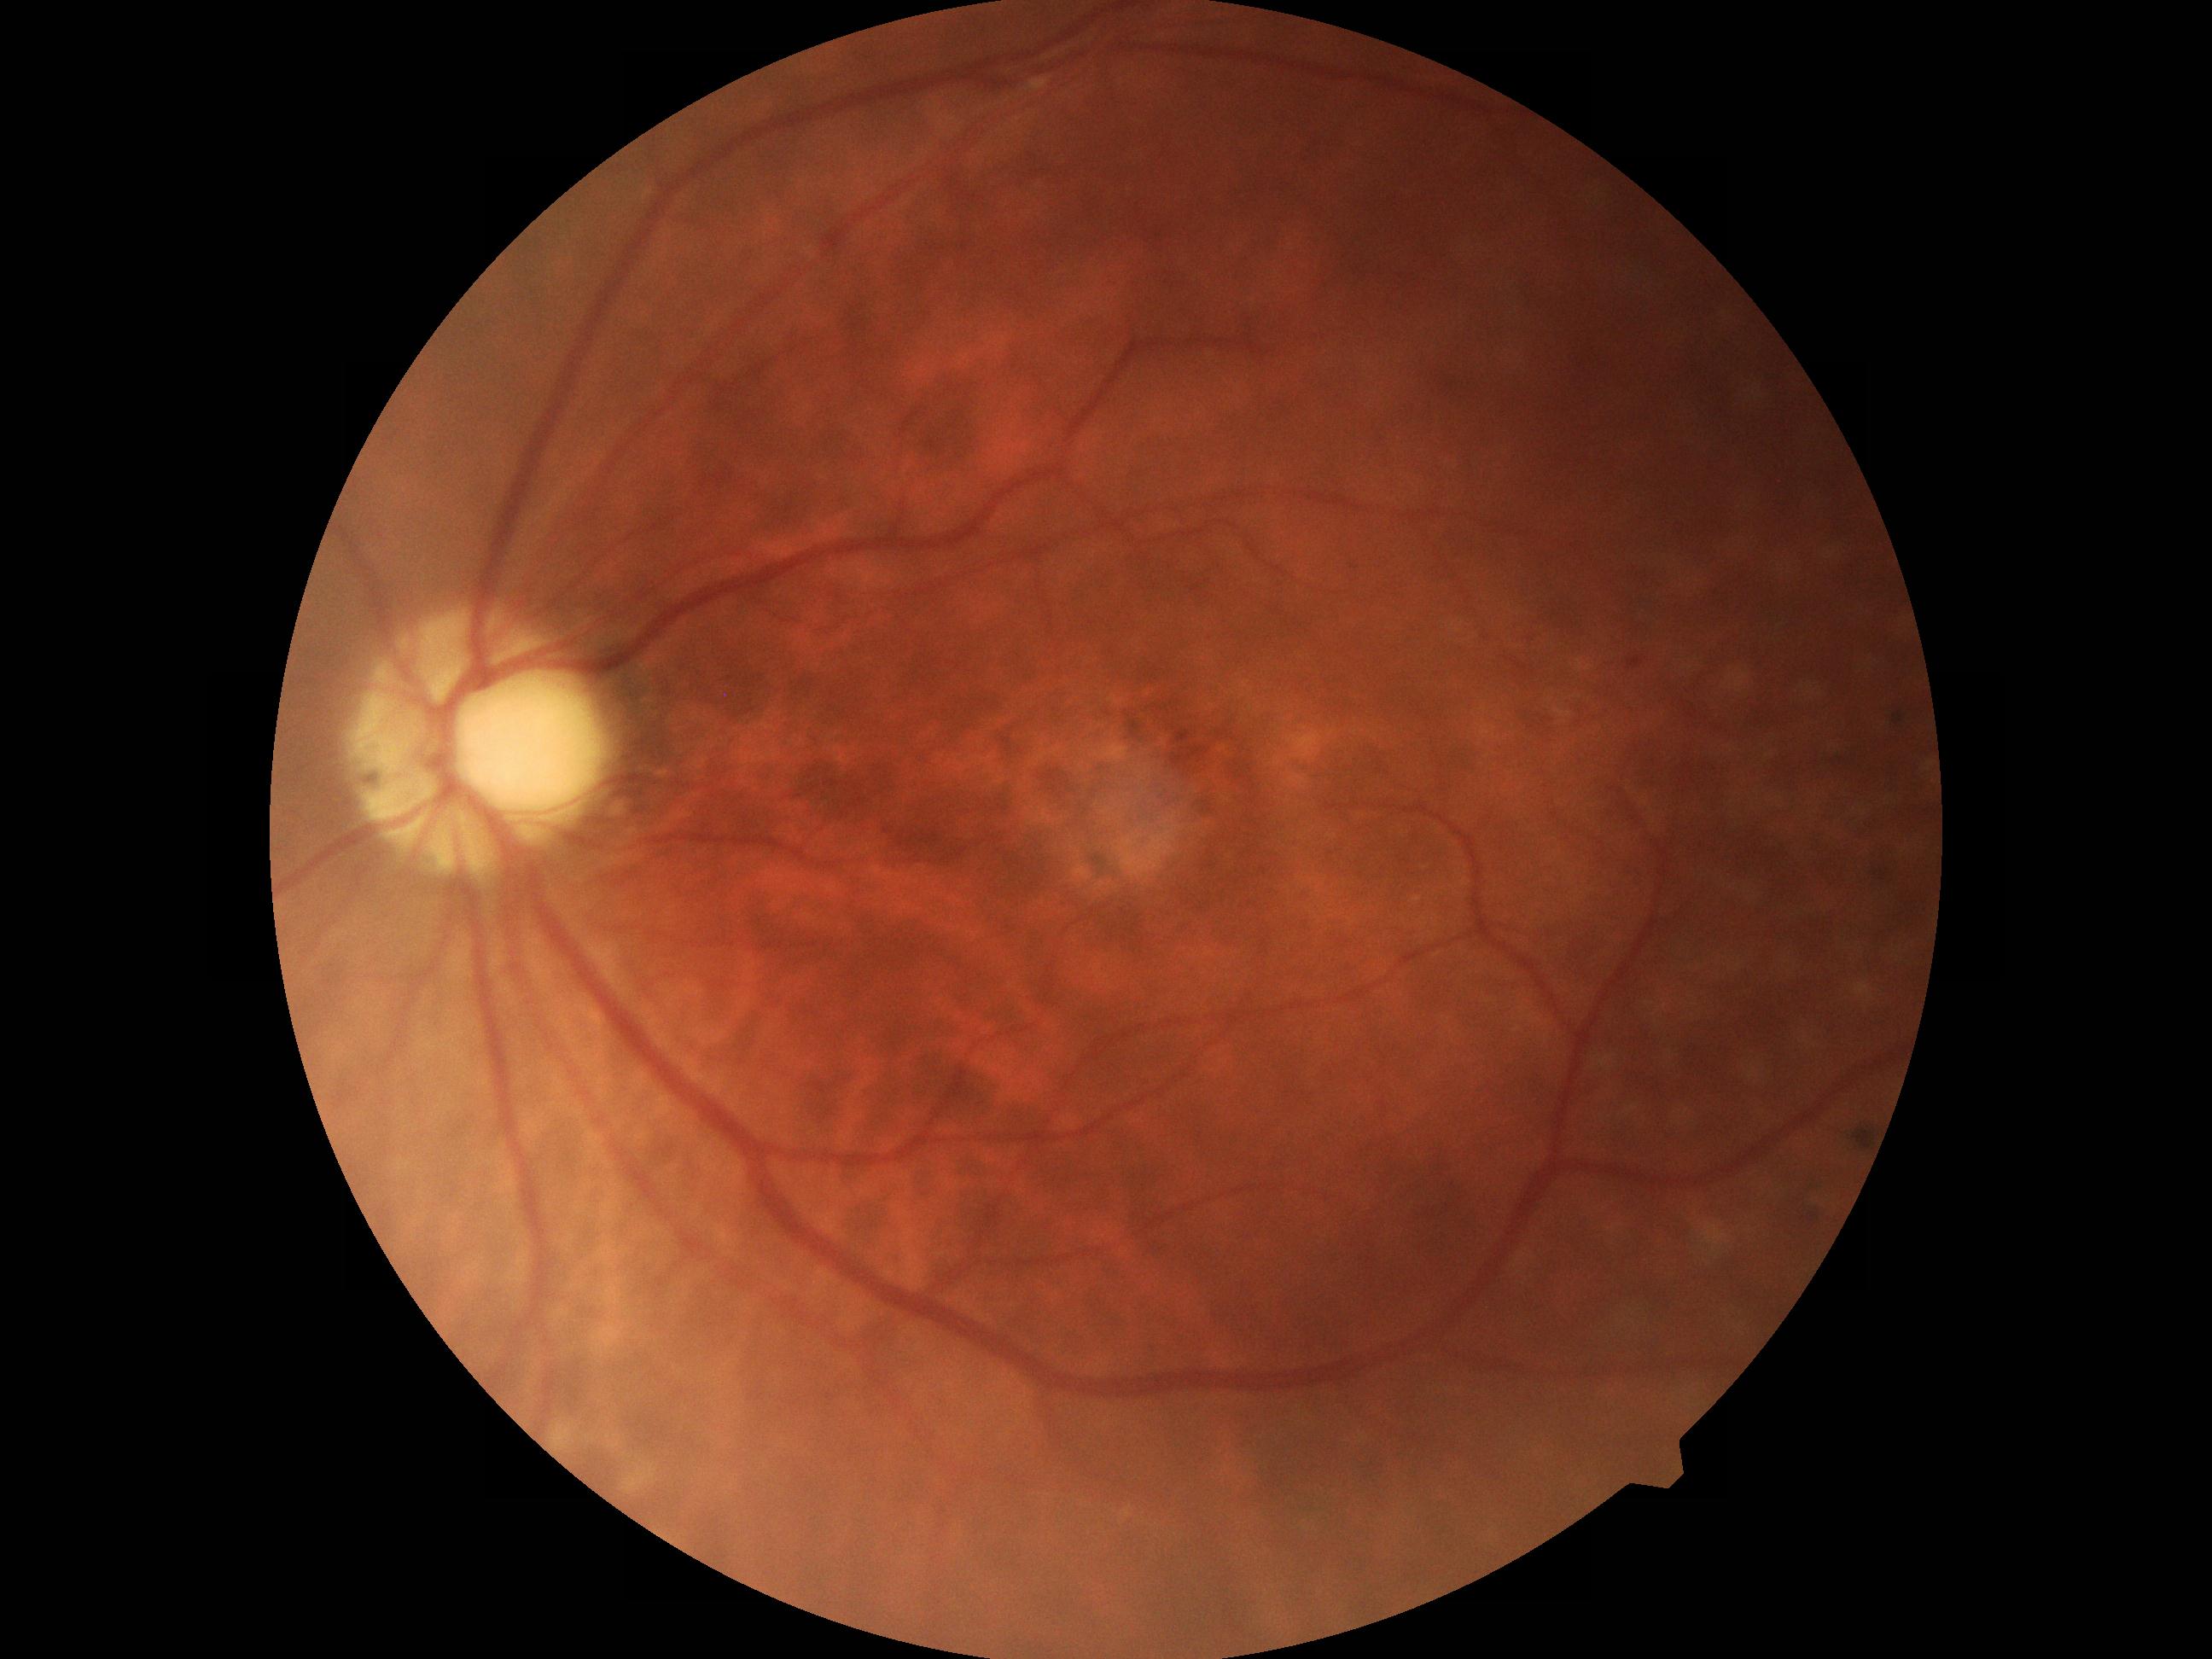 Retinopathy grade: 1.